Pediatric retinal photograph (wide-field); image size 640x480:
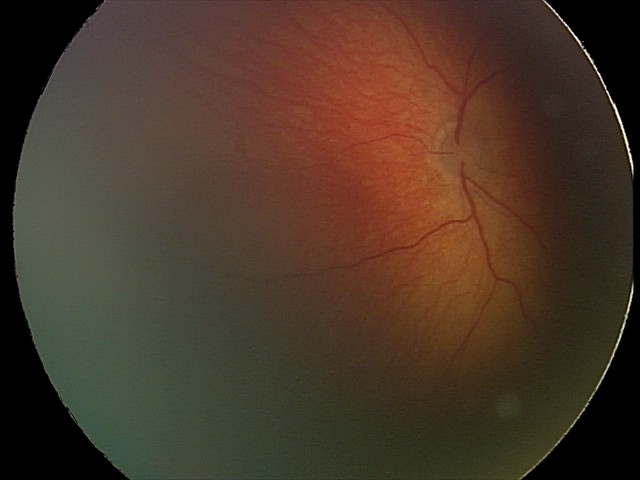

Screening diagnosis: retinal hemorrhages.